2352 x 1568 pixels: 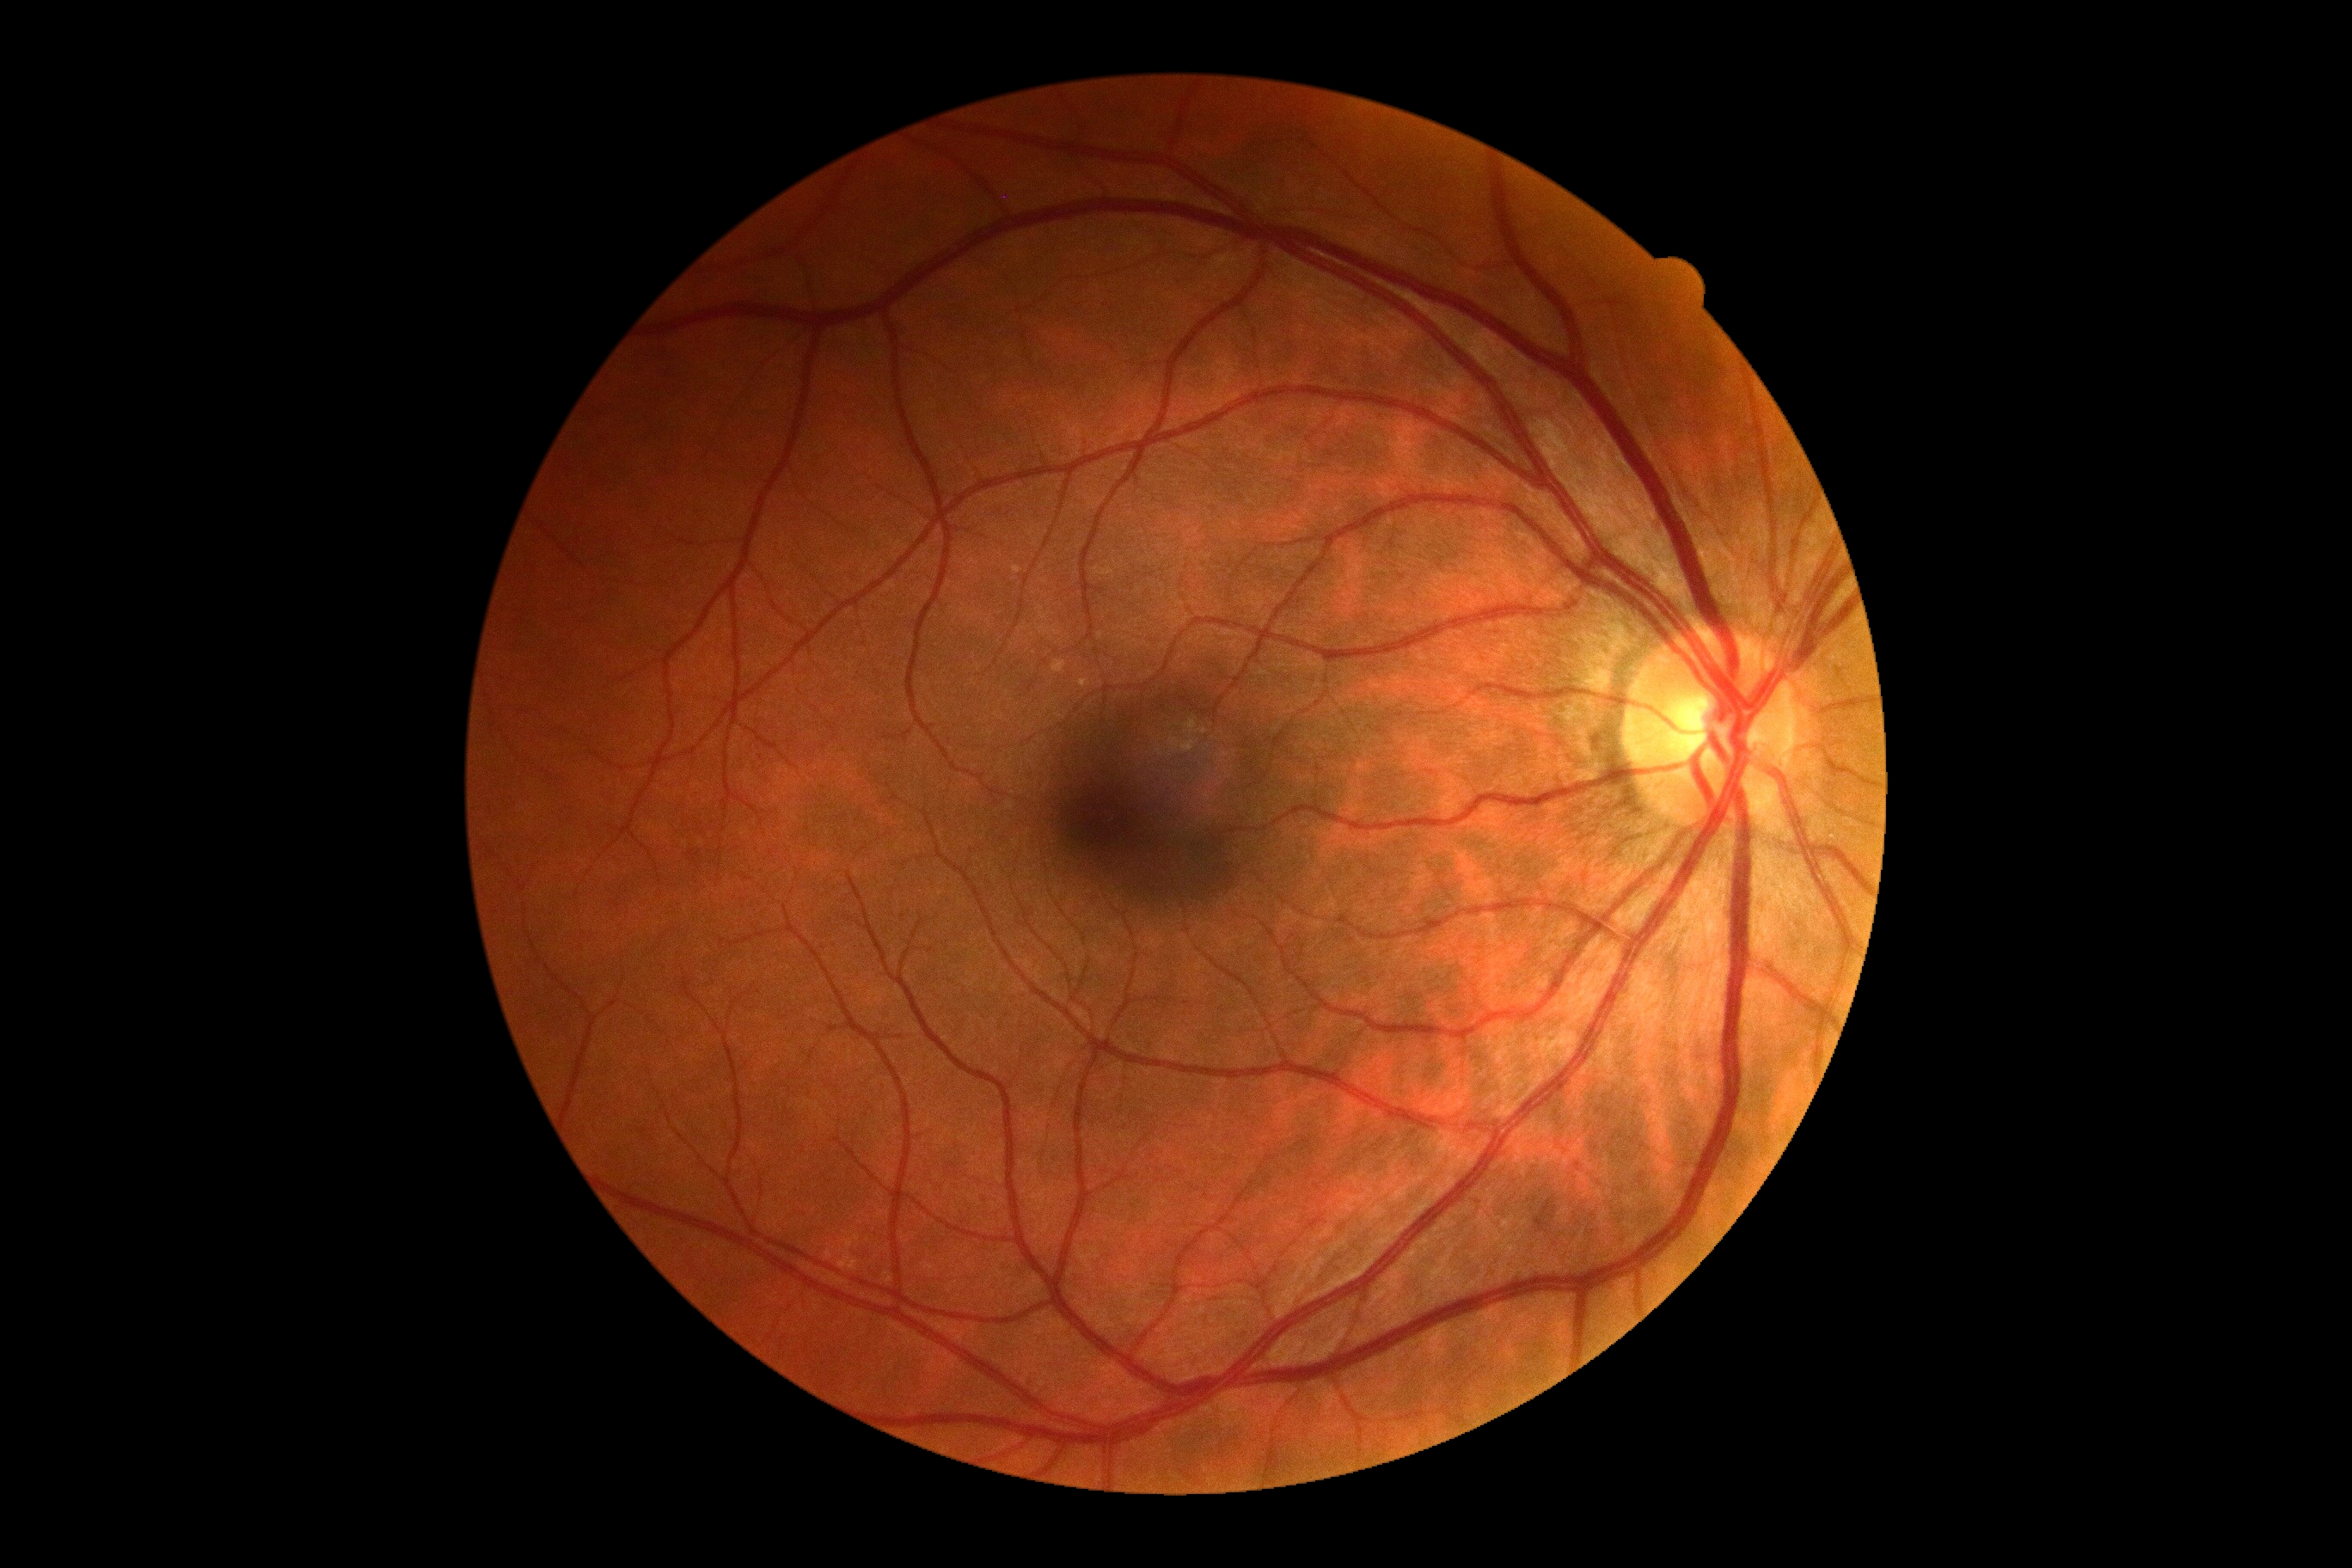
{
  "dr_impression": "no DR findings",
  "dr_grade": "0"
}